45° FOV.
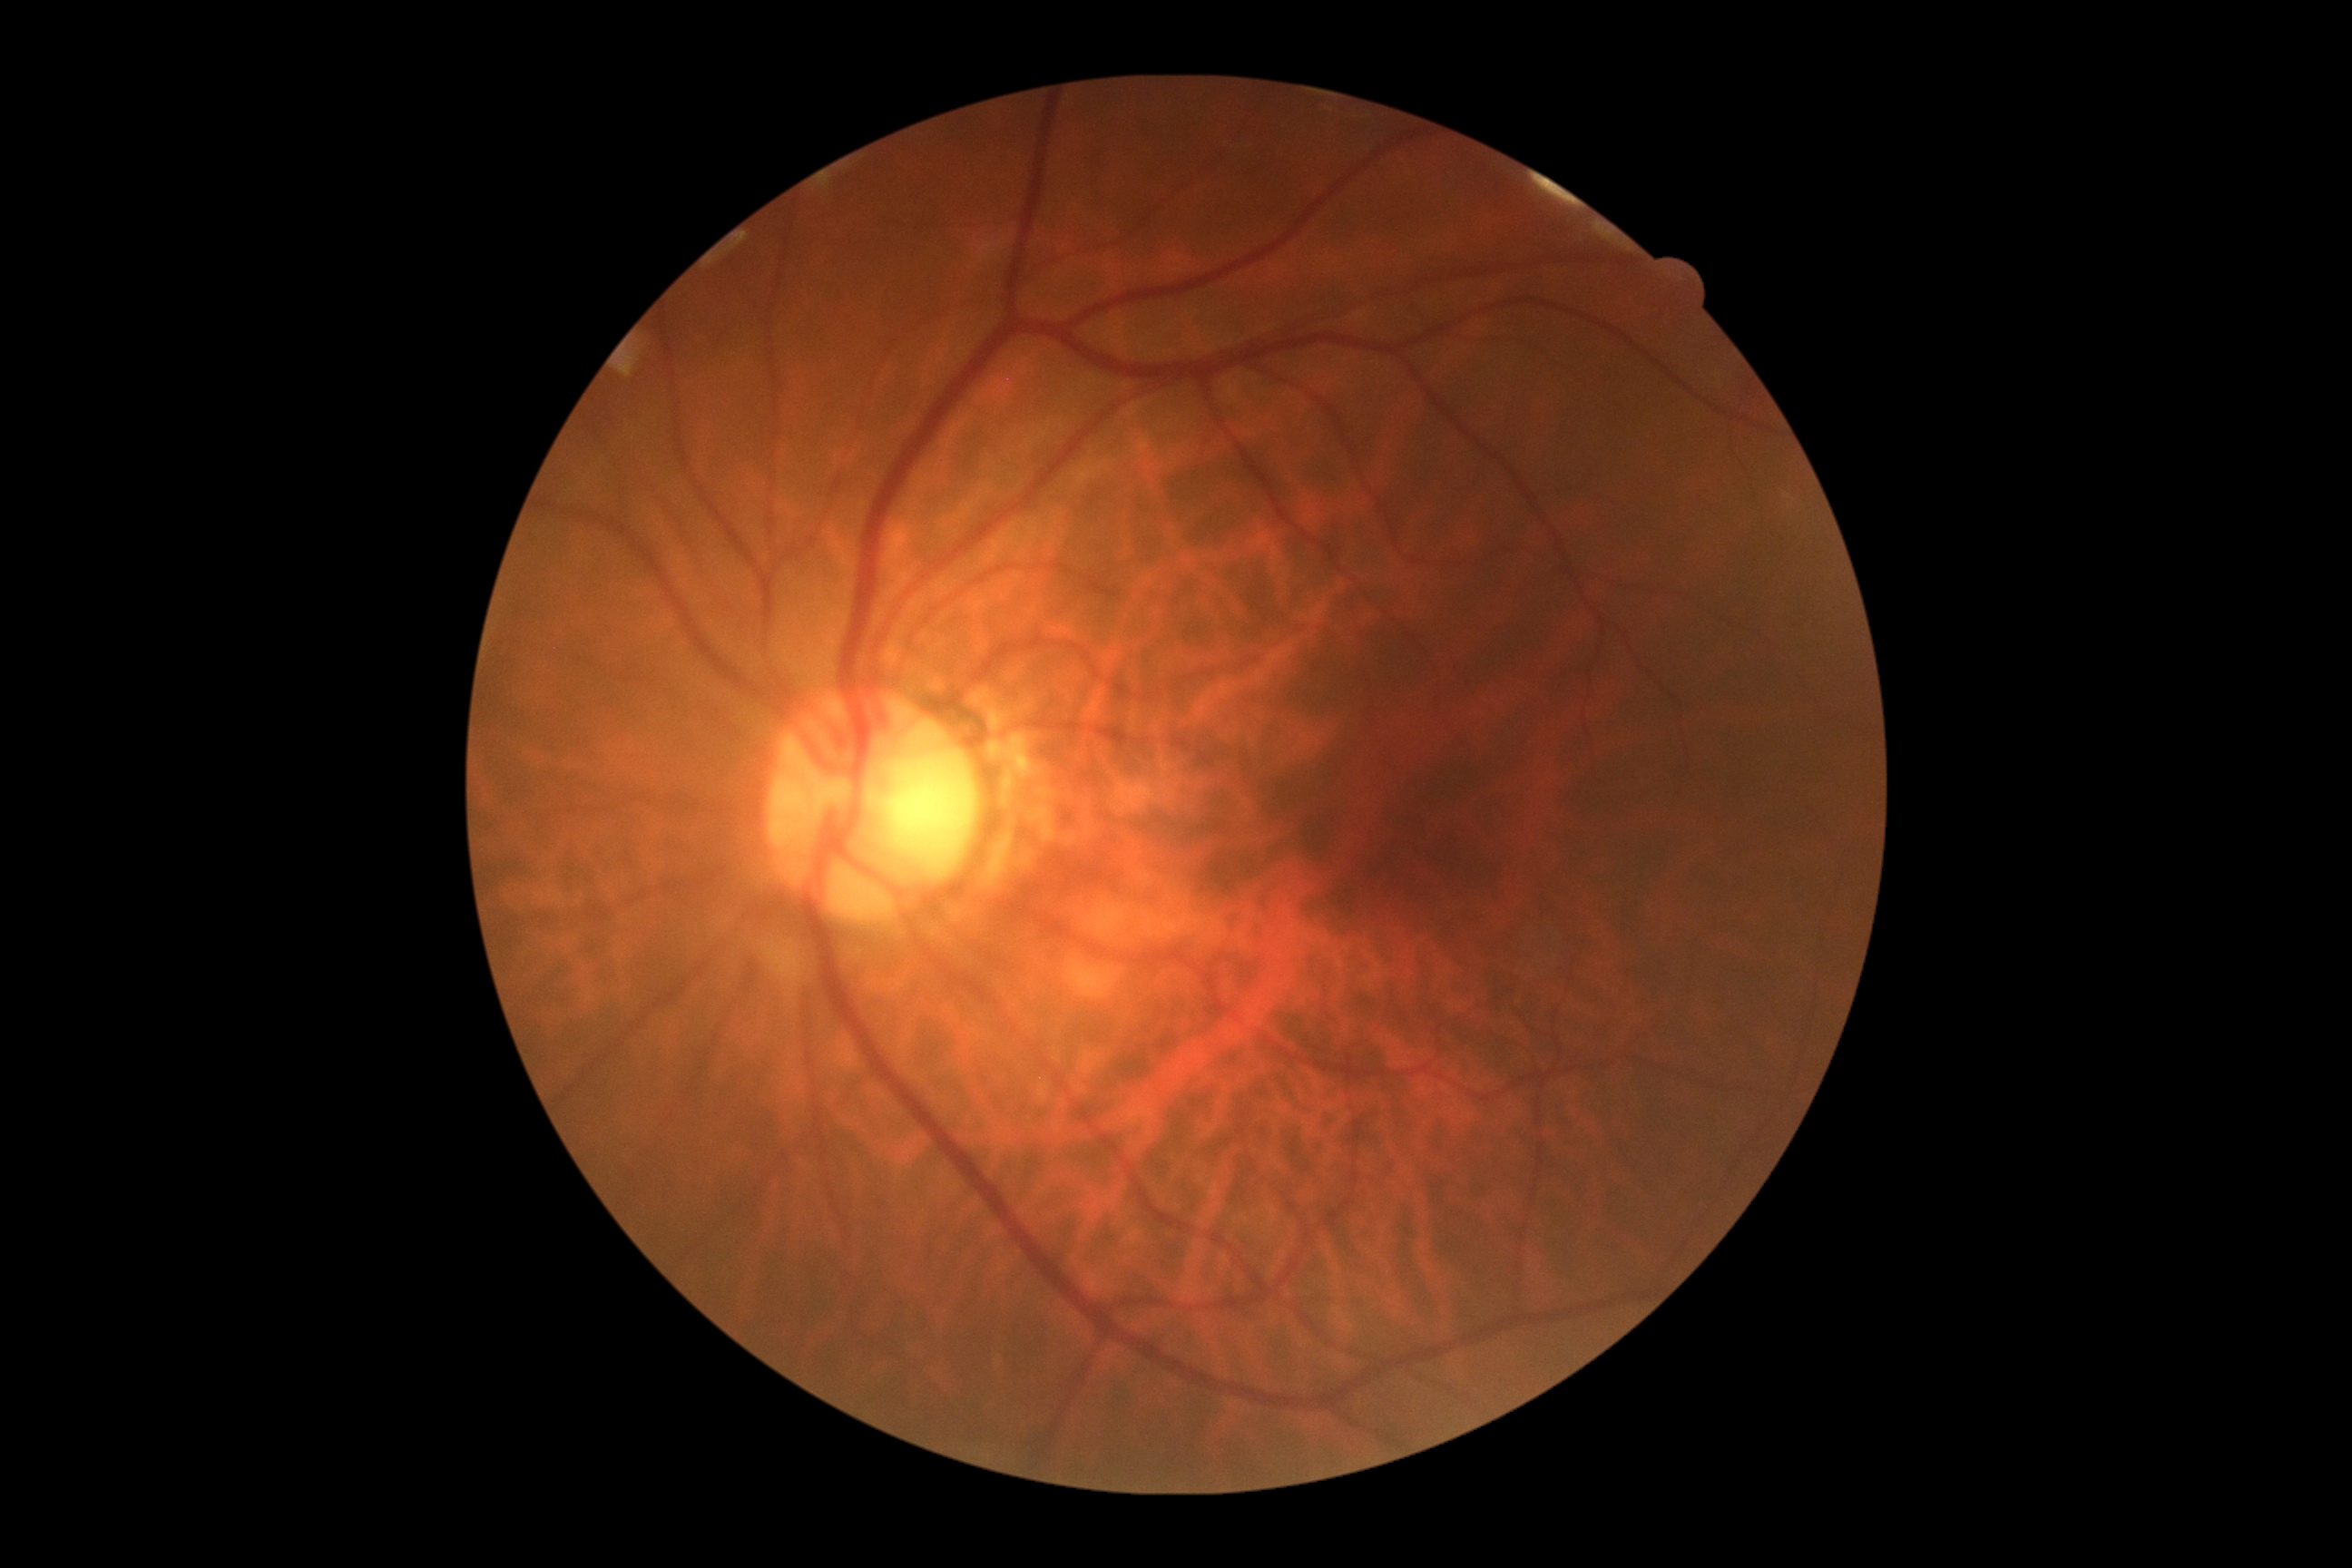

Diabetic retinopathy (DR) is grade 0.